Wide-field fundus photograph from neonatal ROP screening · captured with the Phoenix ICON (100° field of view):
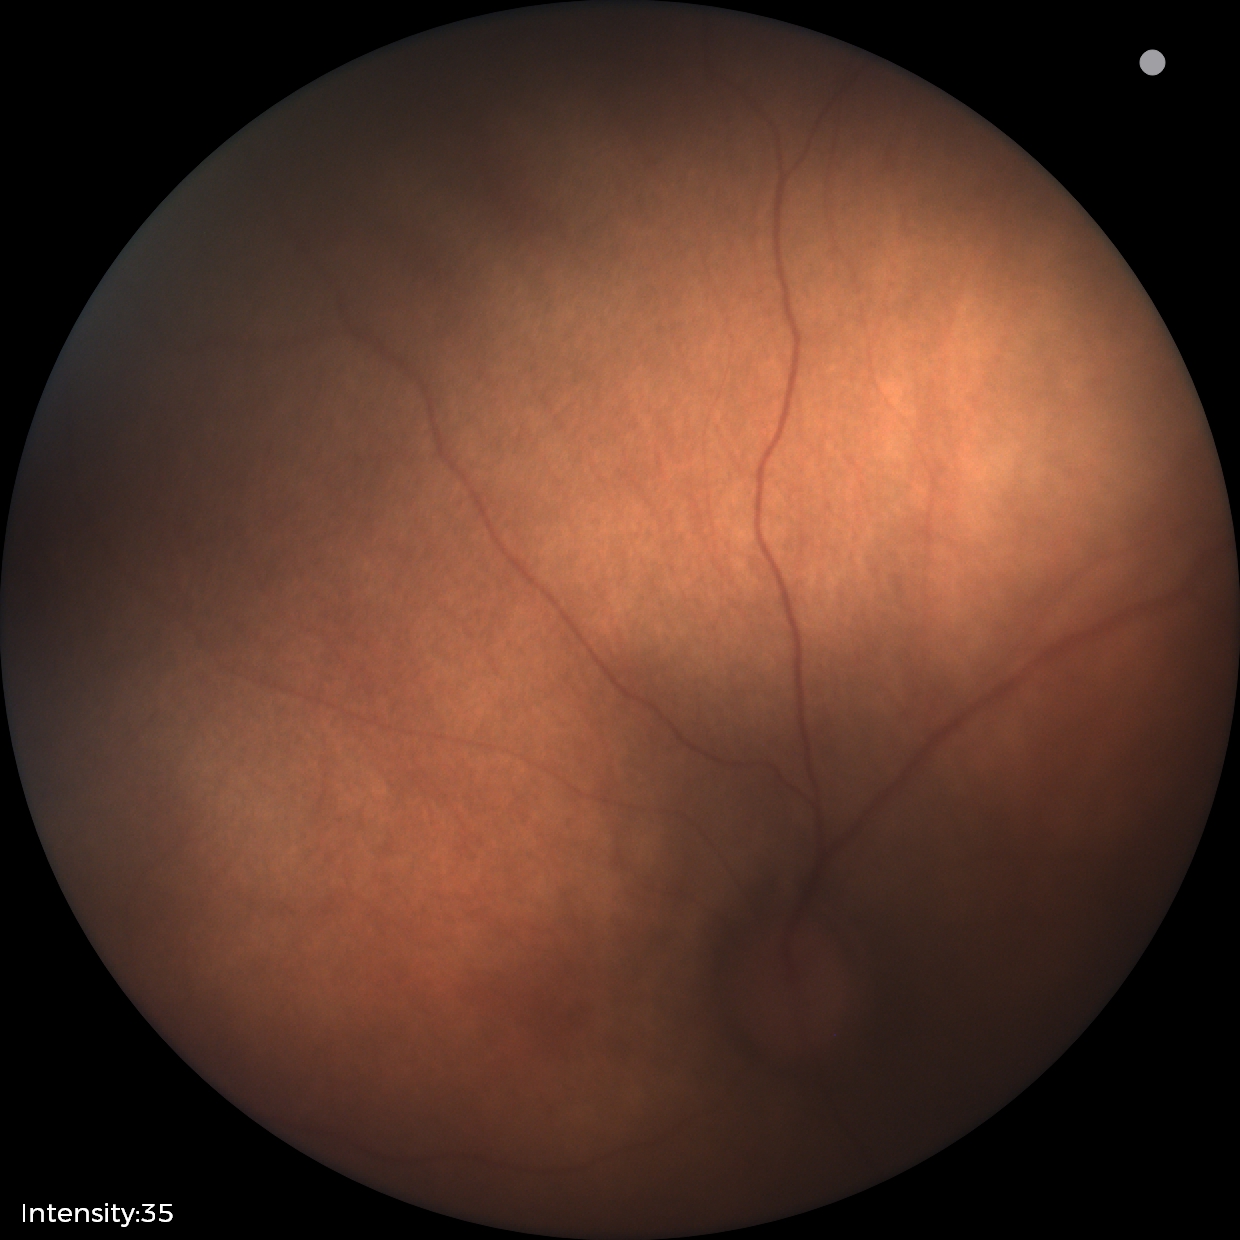
No retinal pathology identified on screening.